Fundus photo.
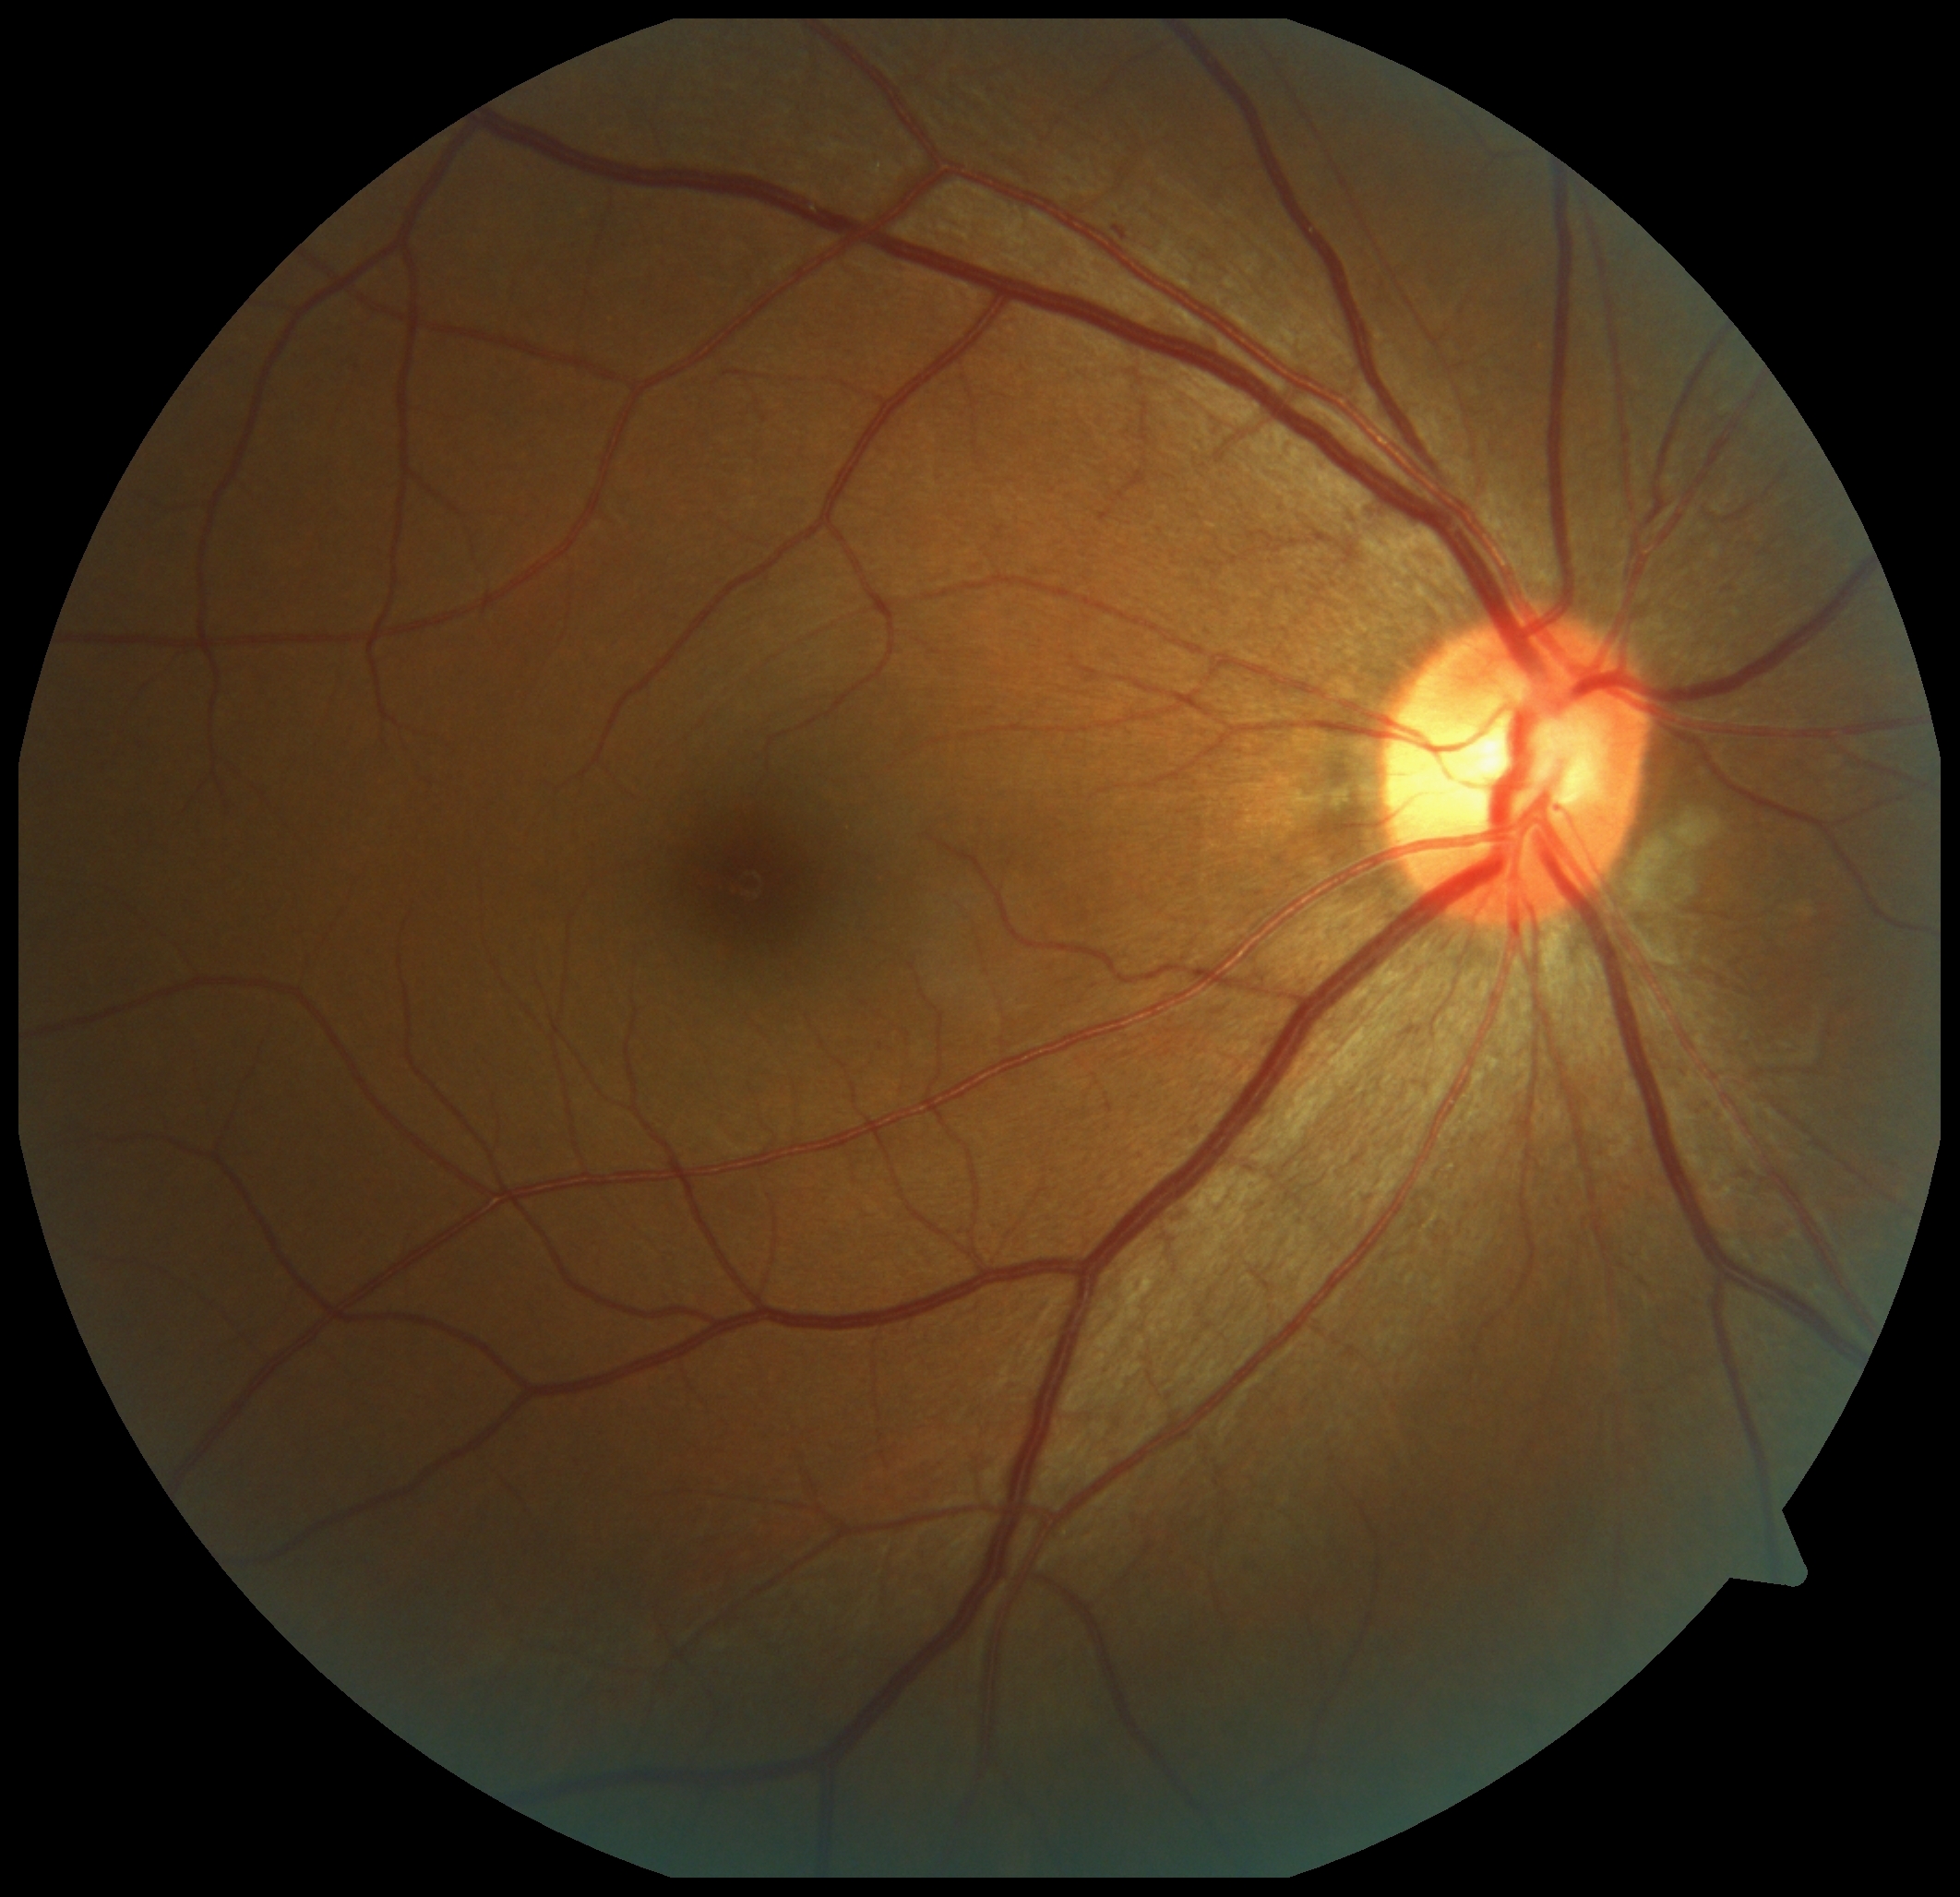
Diabetic retinopathy (DR): 1.